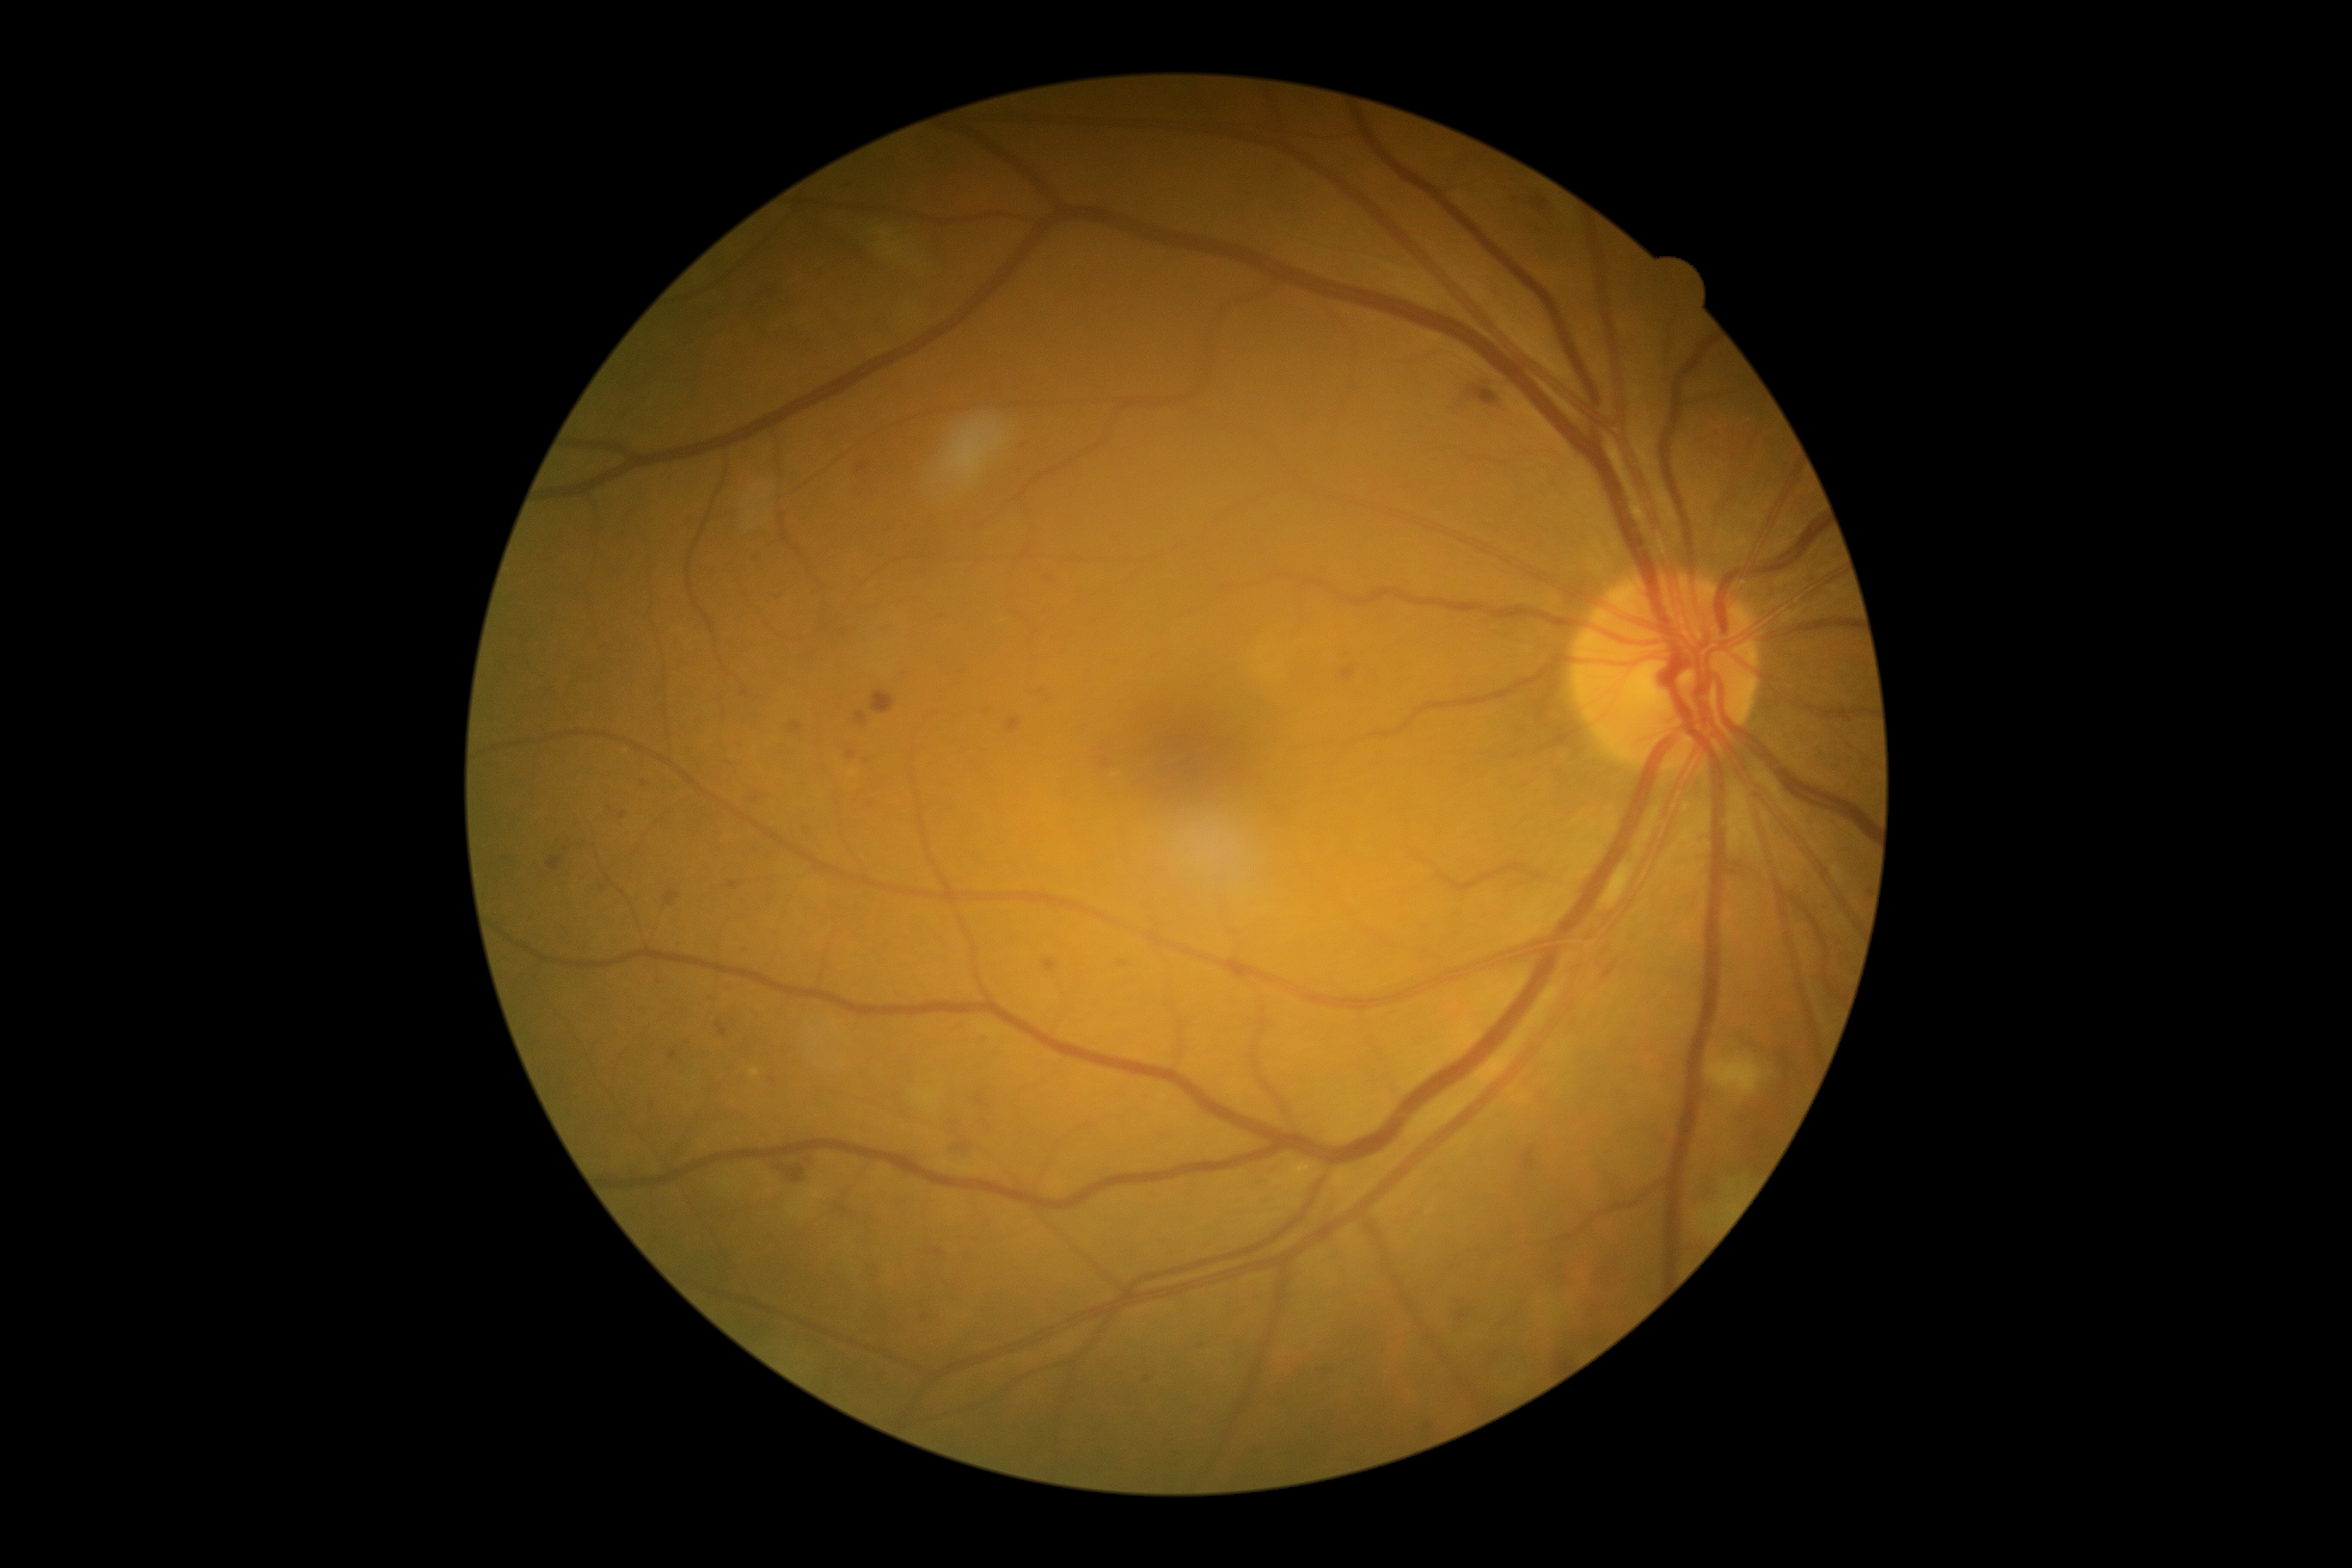

Diabetic retinopathy (DR): grade 2 (moderate NPDR)
Selected lesions:
microaneurysms (MAs) (more not shown): 744/943/750/953; 855/713/867/726; 857/463/867/474; 1514/195/1522/205; 807/1158/816/1165; 1120/962/1129/967; 666/891/680/905; 548/857/563/871; 922/1313/934/1323; 1048/573/1057/582
Smaller MAs around x=939 y=1253; x=951 y=1123; x=687 y=1042; x=774 y=1083; x=603 y=888